Clarity RetCam 3, 130° FOV · 640x480px · pediatric wide-field fundus photograph — 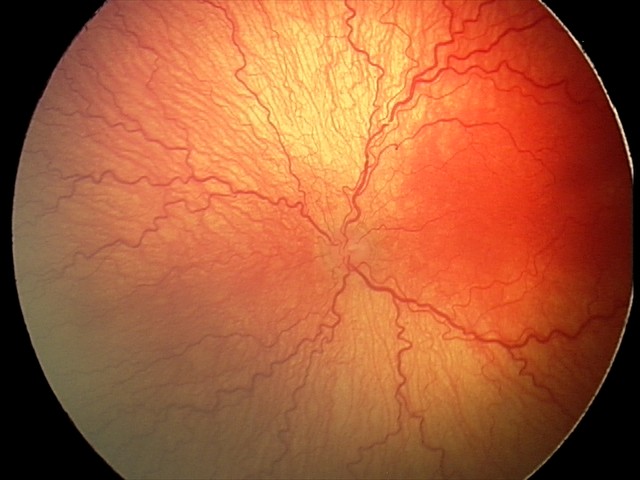
Q: What is the screening diagnosis?
A: A-ROP (aggressive ROP)
Q: Is plus disease present?
A: plus disease — abnormal dilation and tortuosity of the posterior pole retinal vessels